Color fundus image — 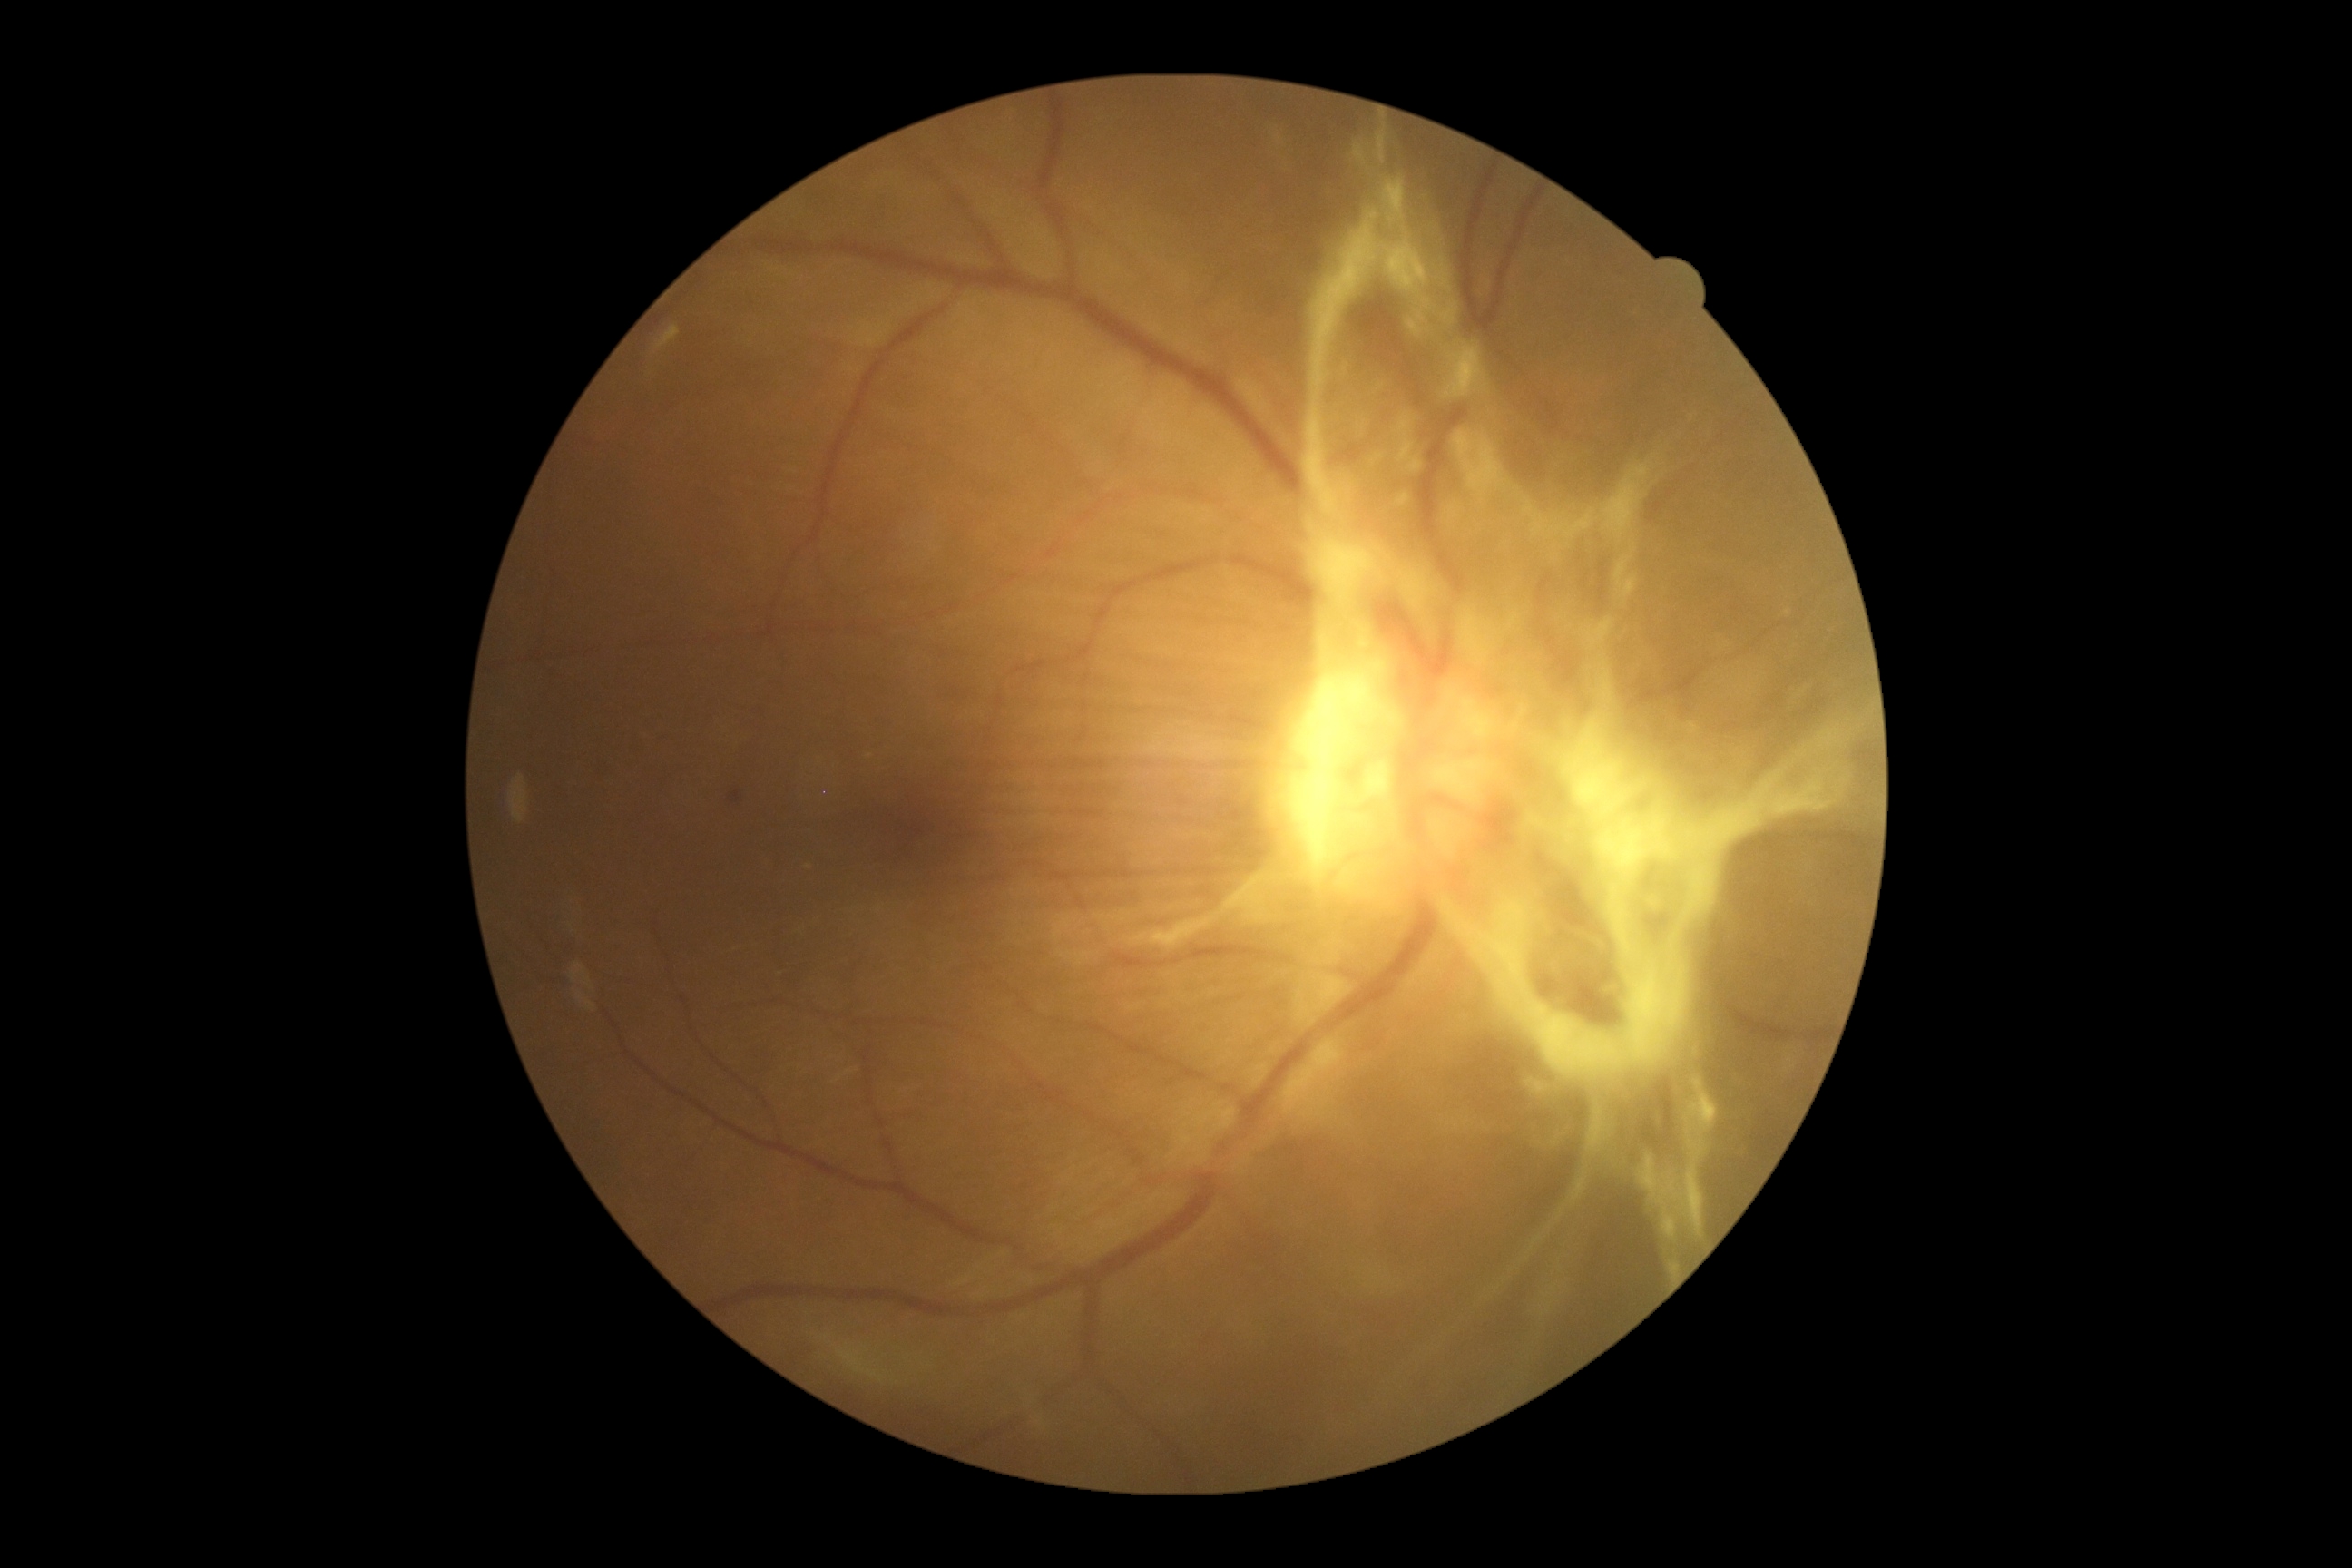

DR: proliferative diabetic retinopathy (grade 4).